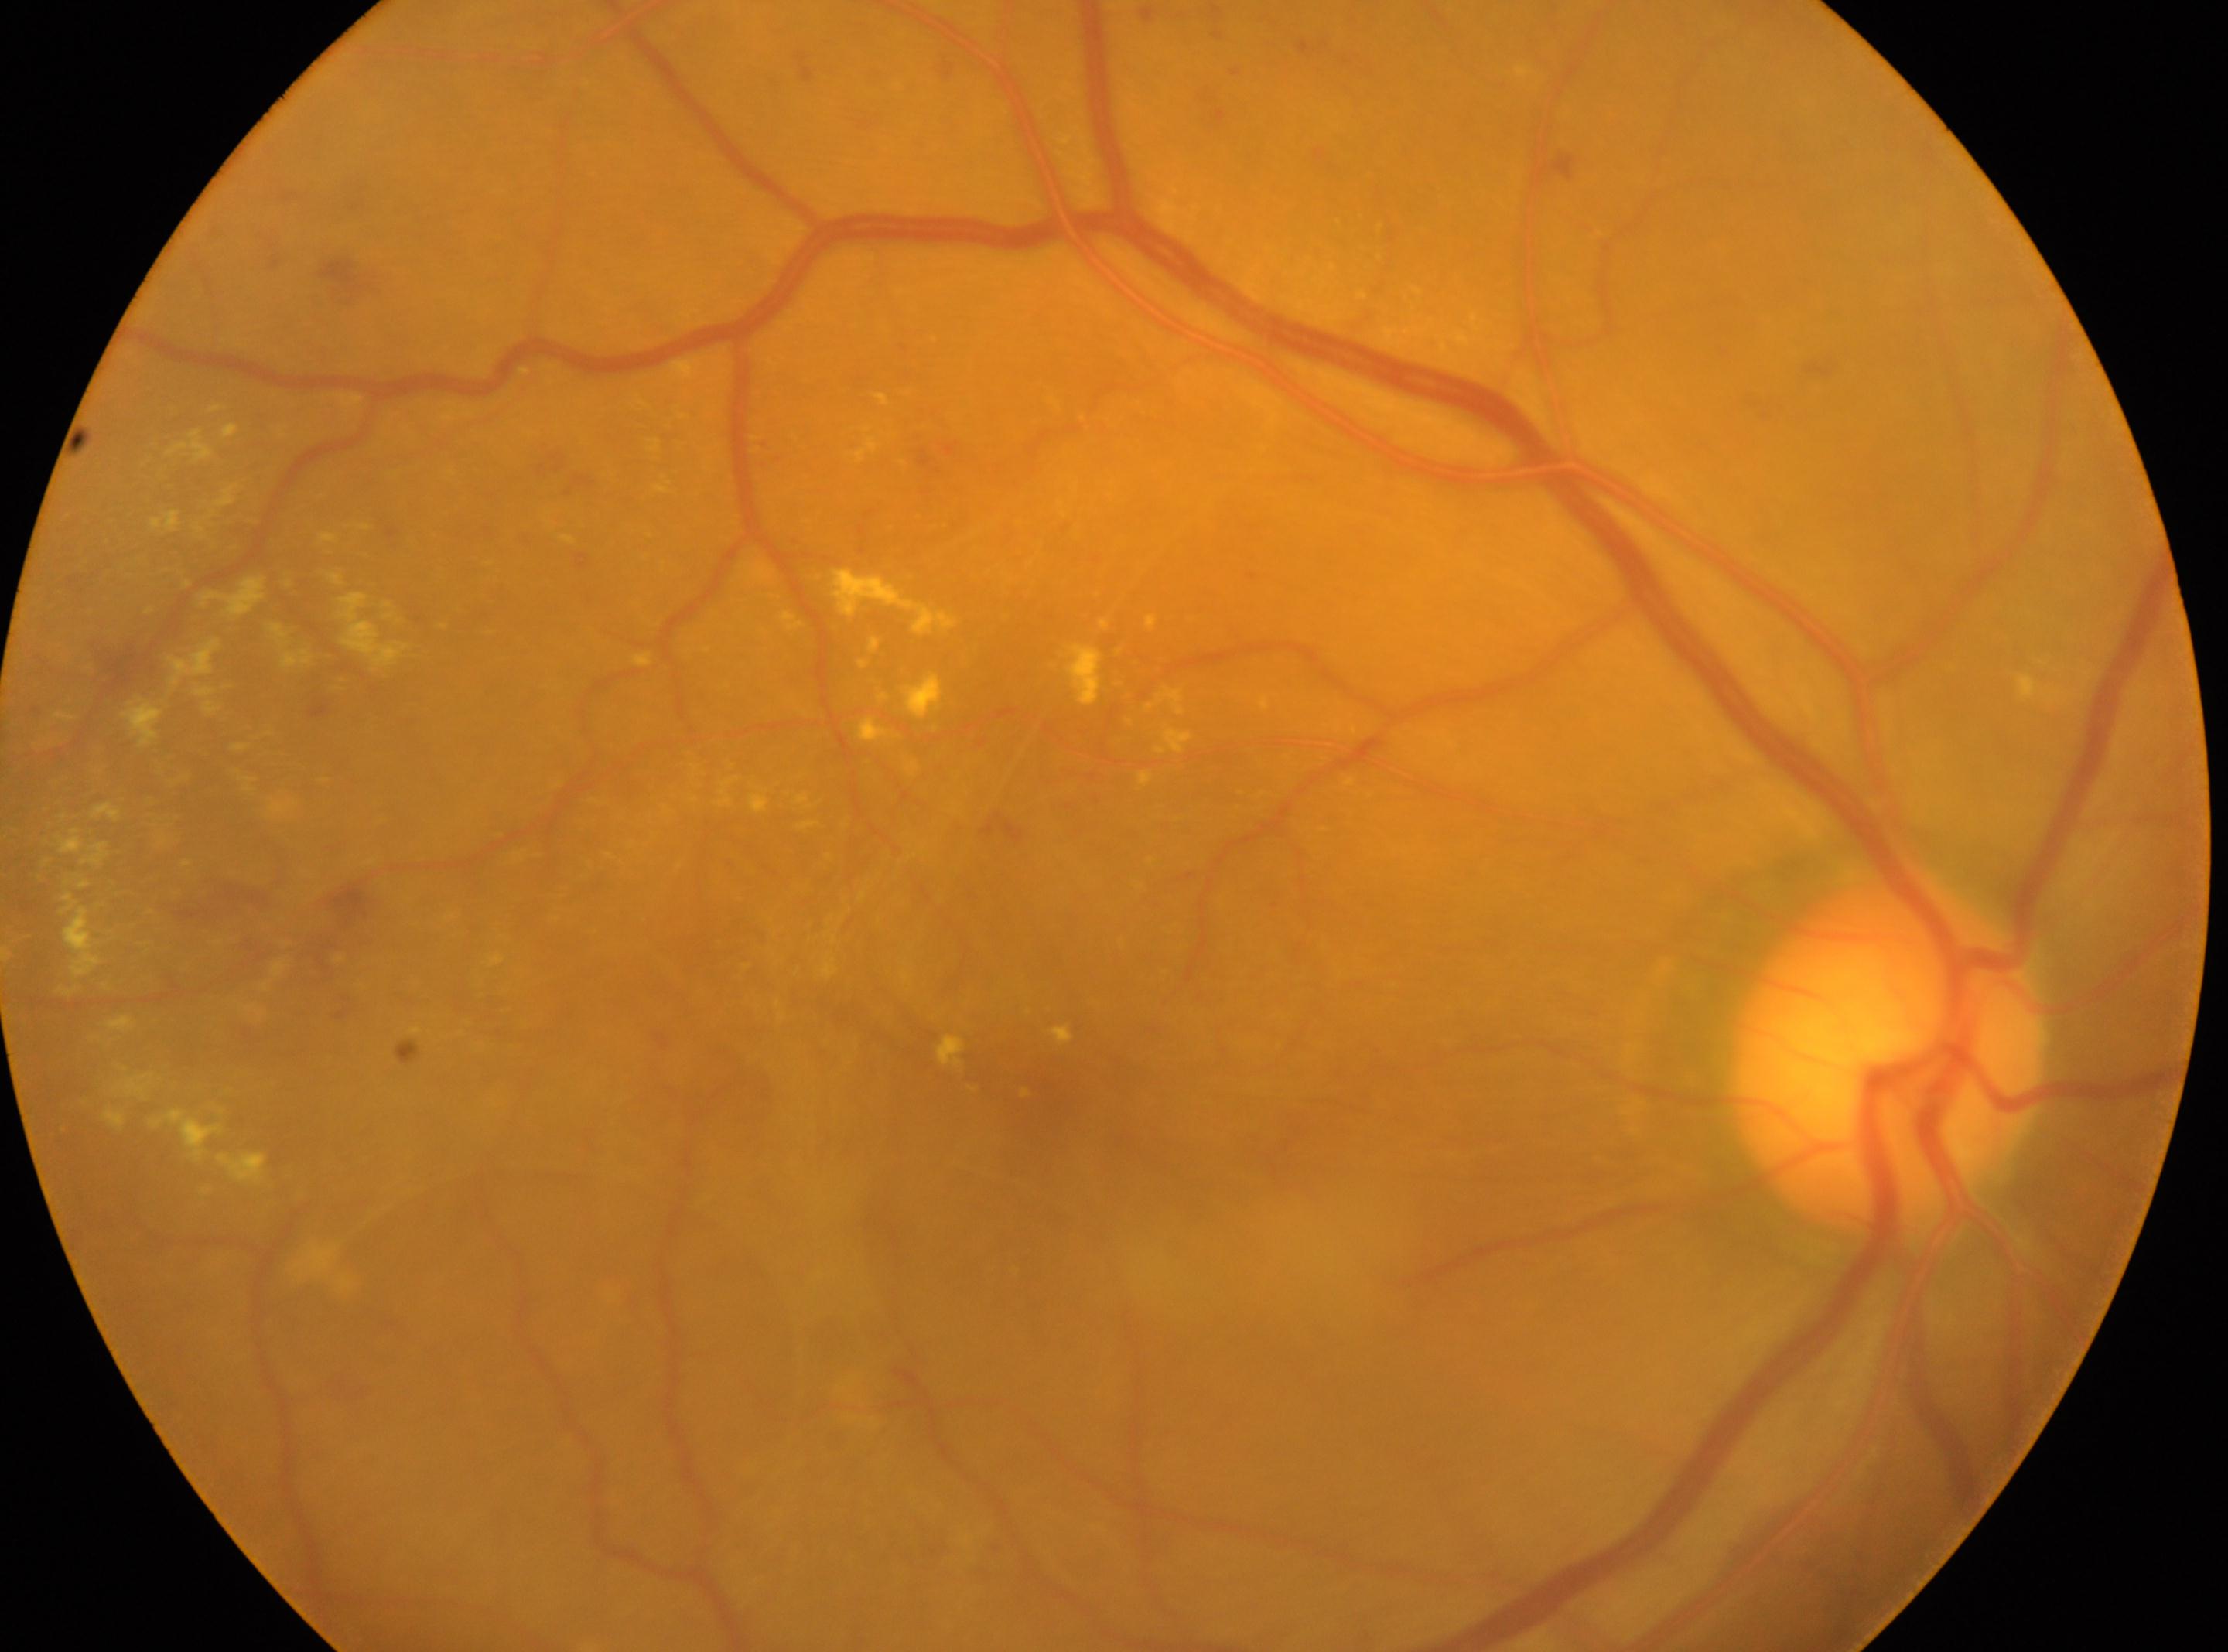

fovea: (x: 1026, y: 1066)
eye: OD
optic_disc: (x: 1888, y: 1056)
dr_grade: proliferative diabetic retinopathy (grade 4)